45° field of view
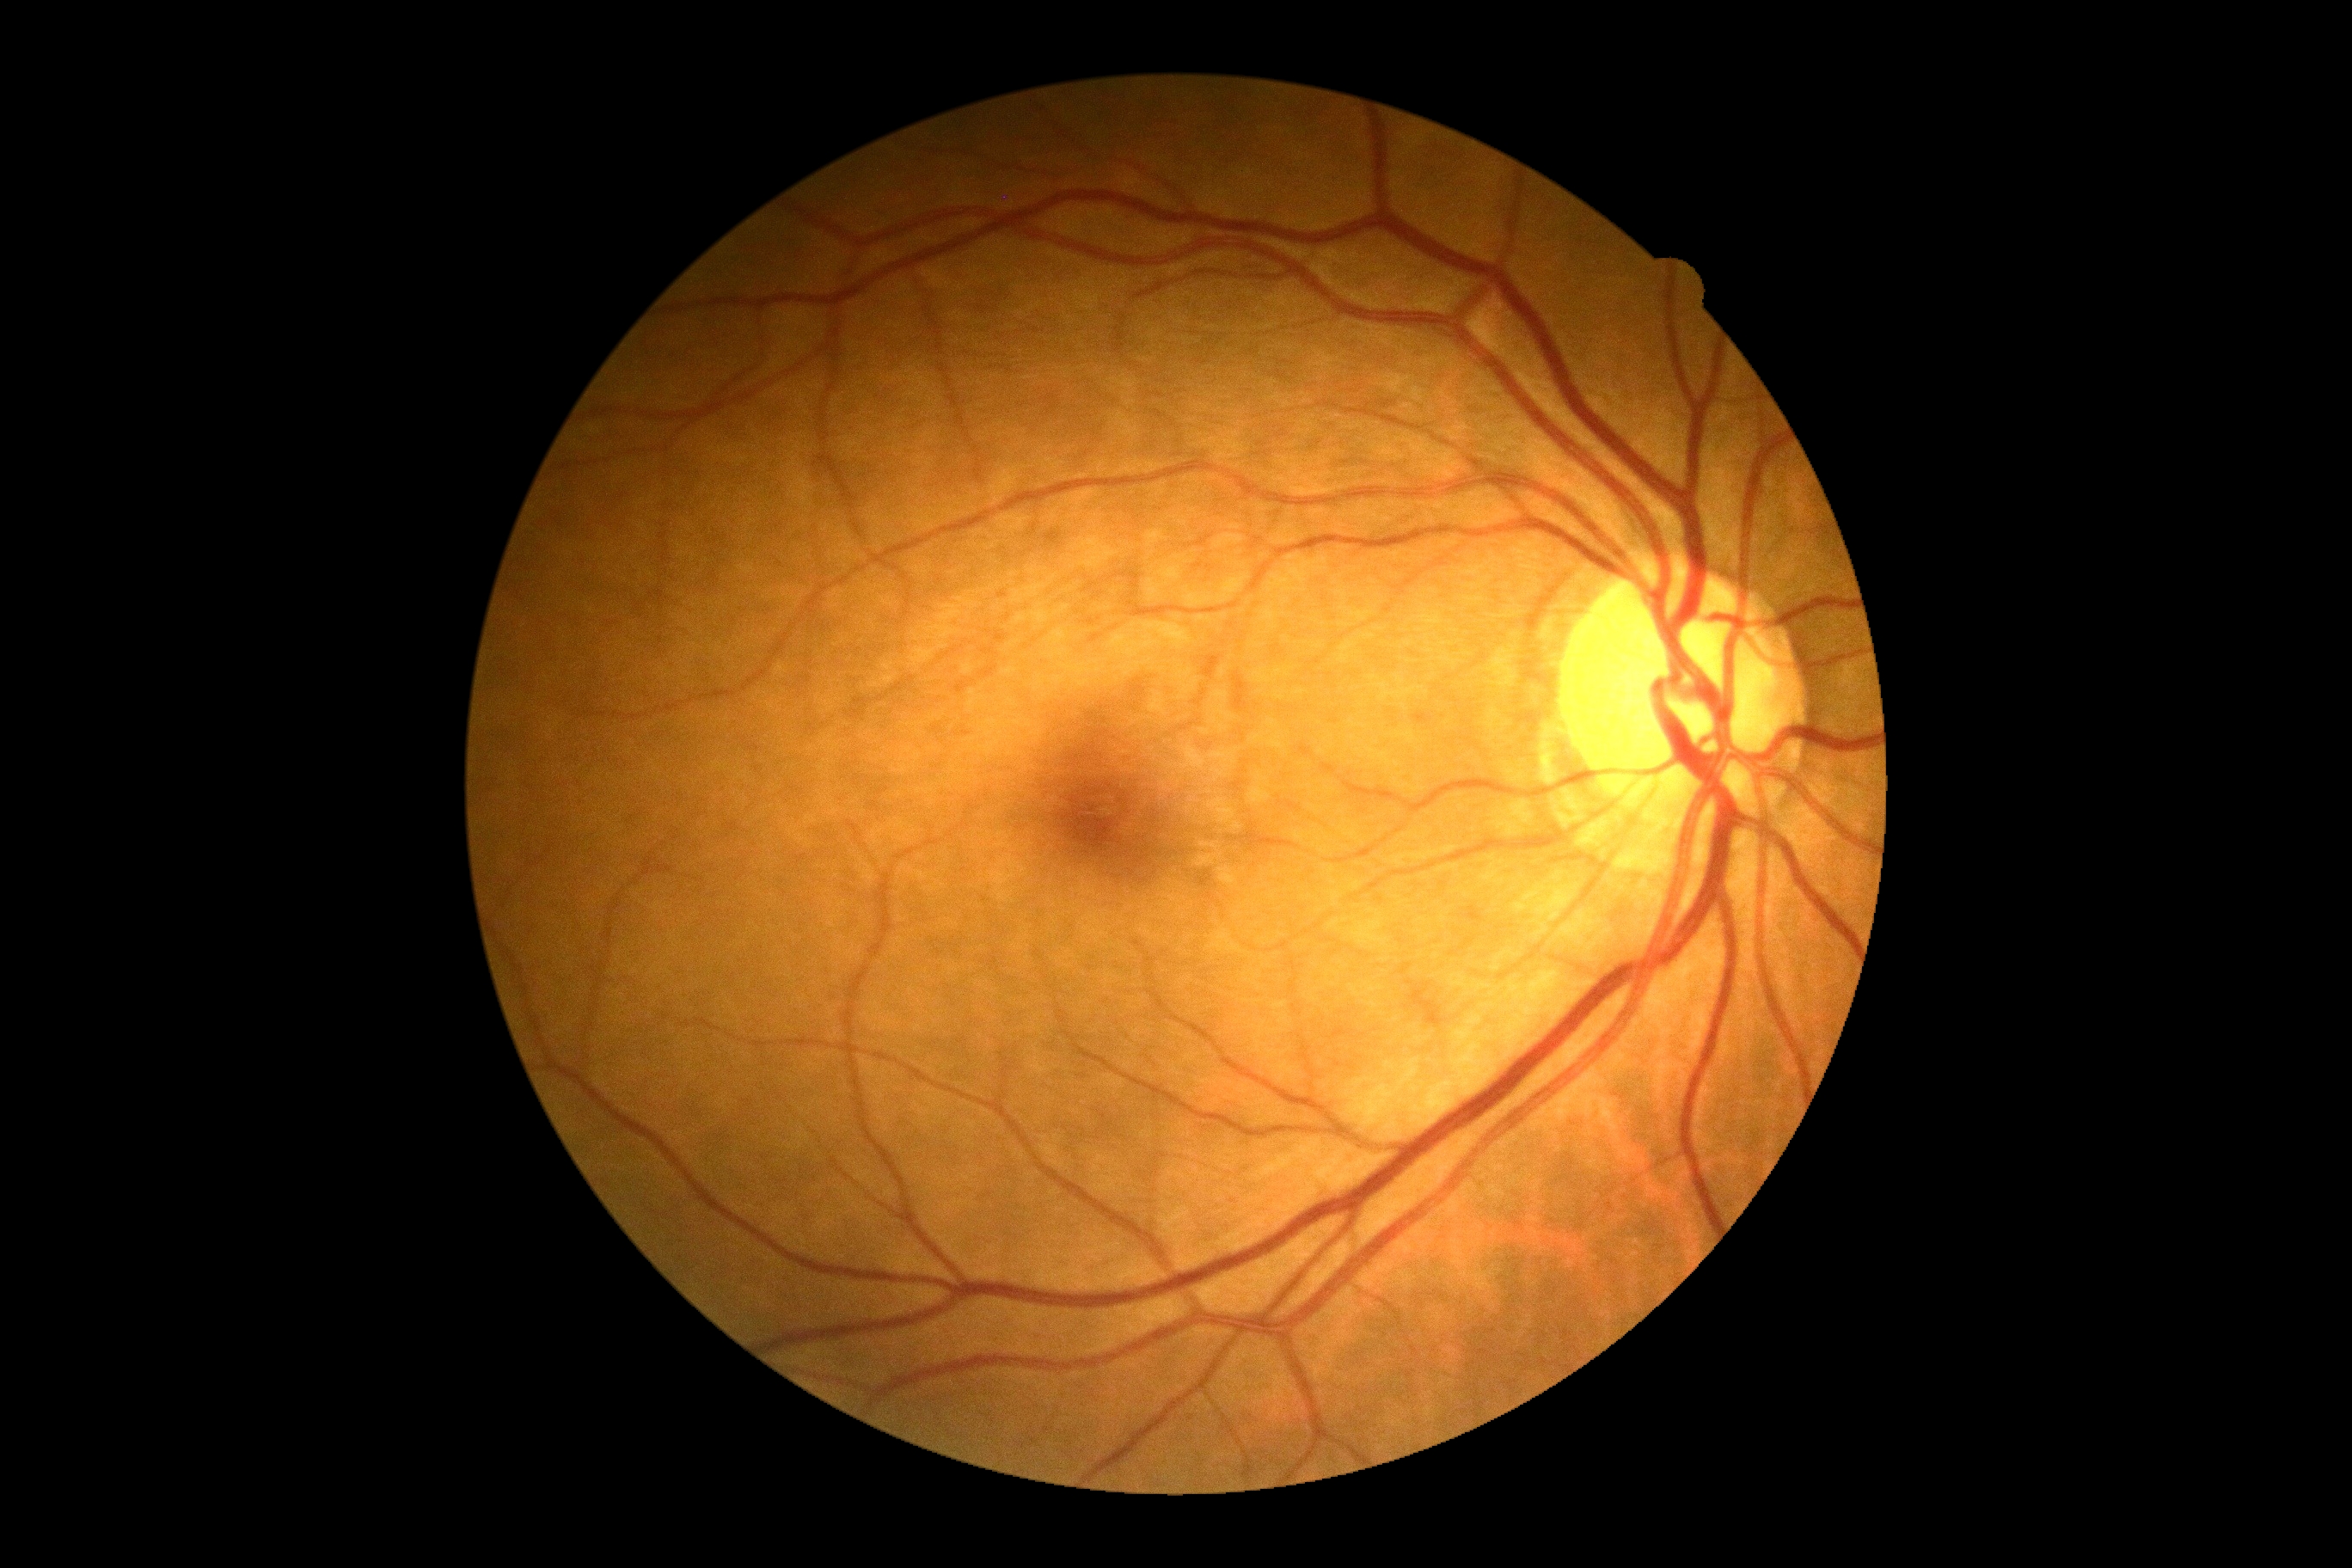 Retinopathy grade: 0 (no apparent retinopathy).